30° field of view. Age 63. Captured without pupil dilation. Female patient. Acquired with a Topcon TRC-NW400. 2212 by 1661 pixels. Refraction: sphere -3.25 D, cylinder -0.5 D, axis 72°. Axial length (AL) 25.78 mm. IOP 15 mmHg (pneumatic tonometry): 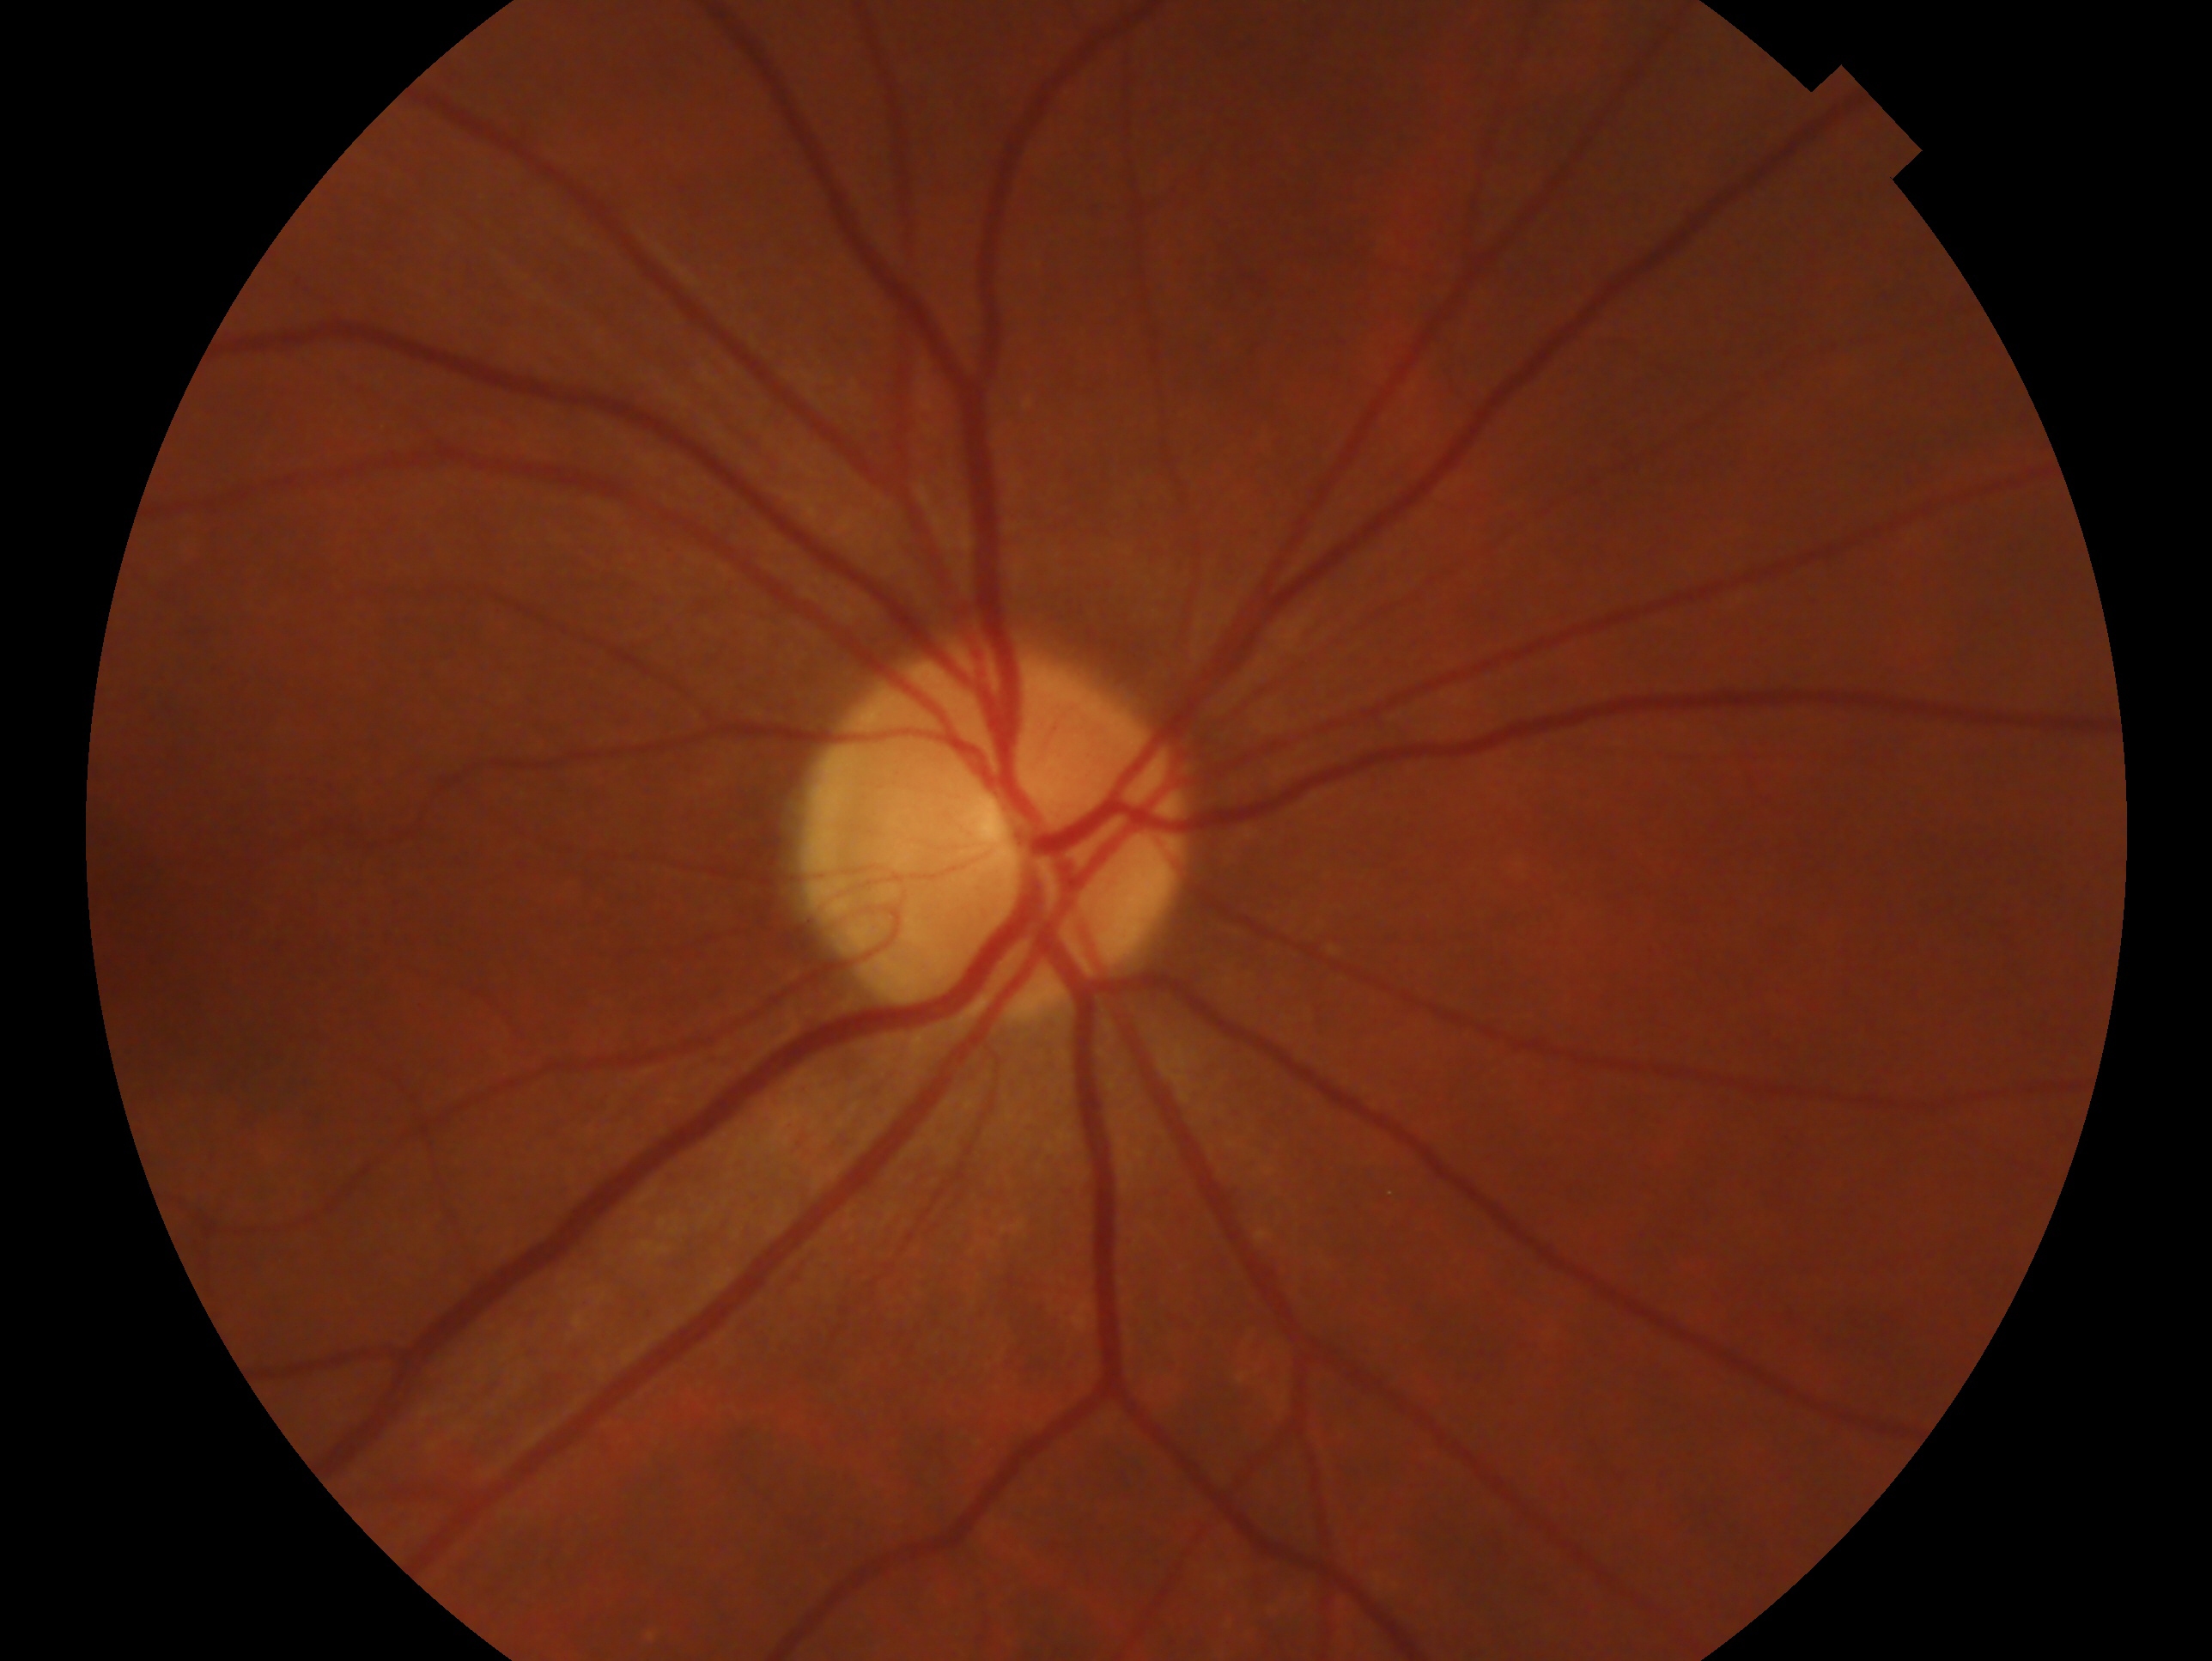
glaucoma assessment: negative for glaucoma | eye: OD.